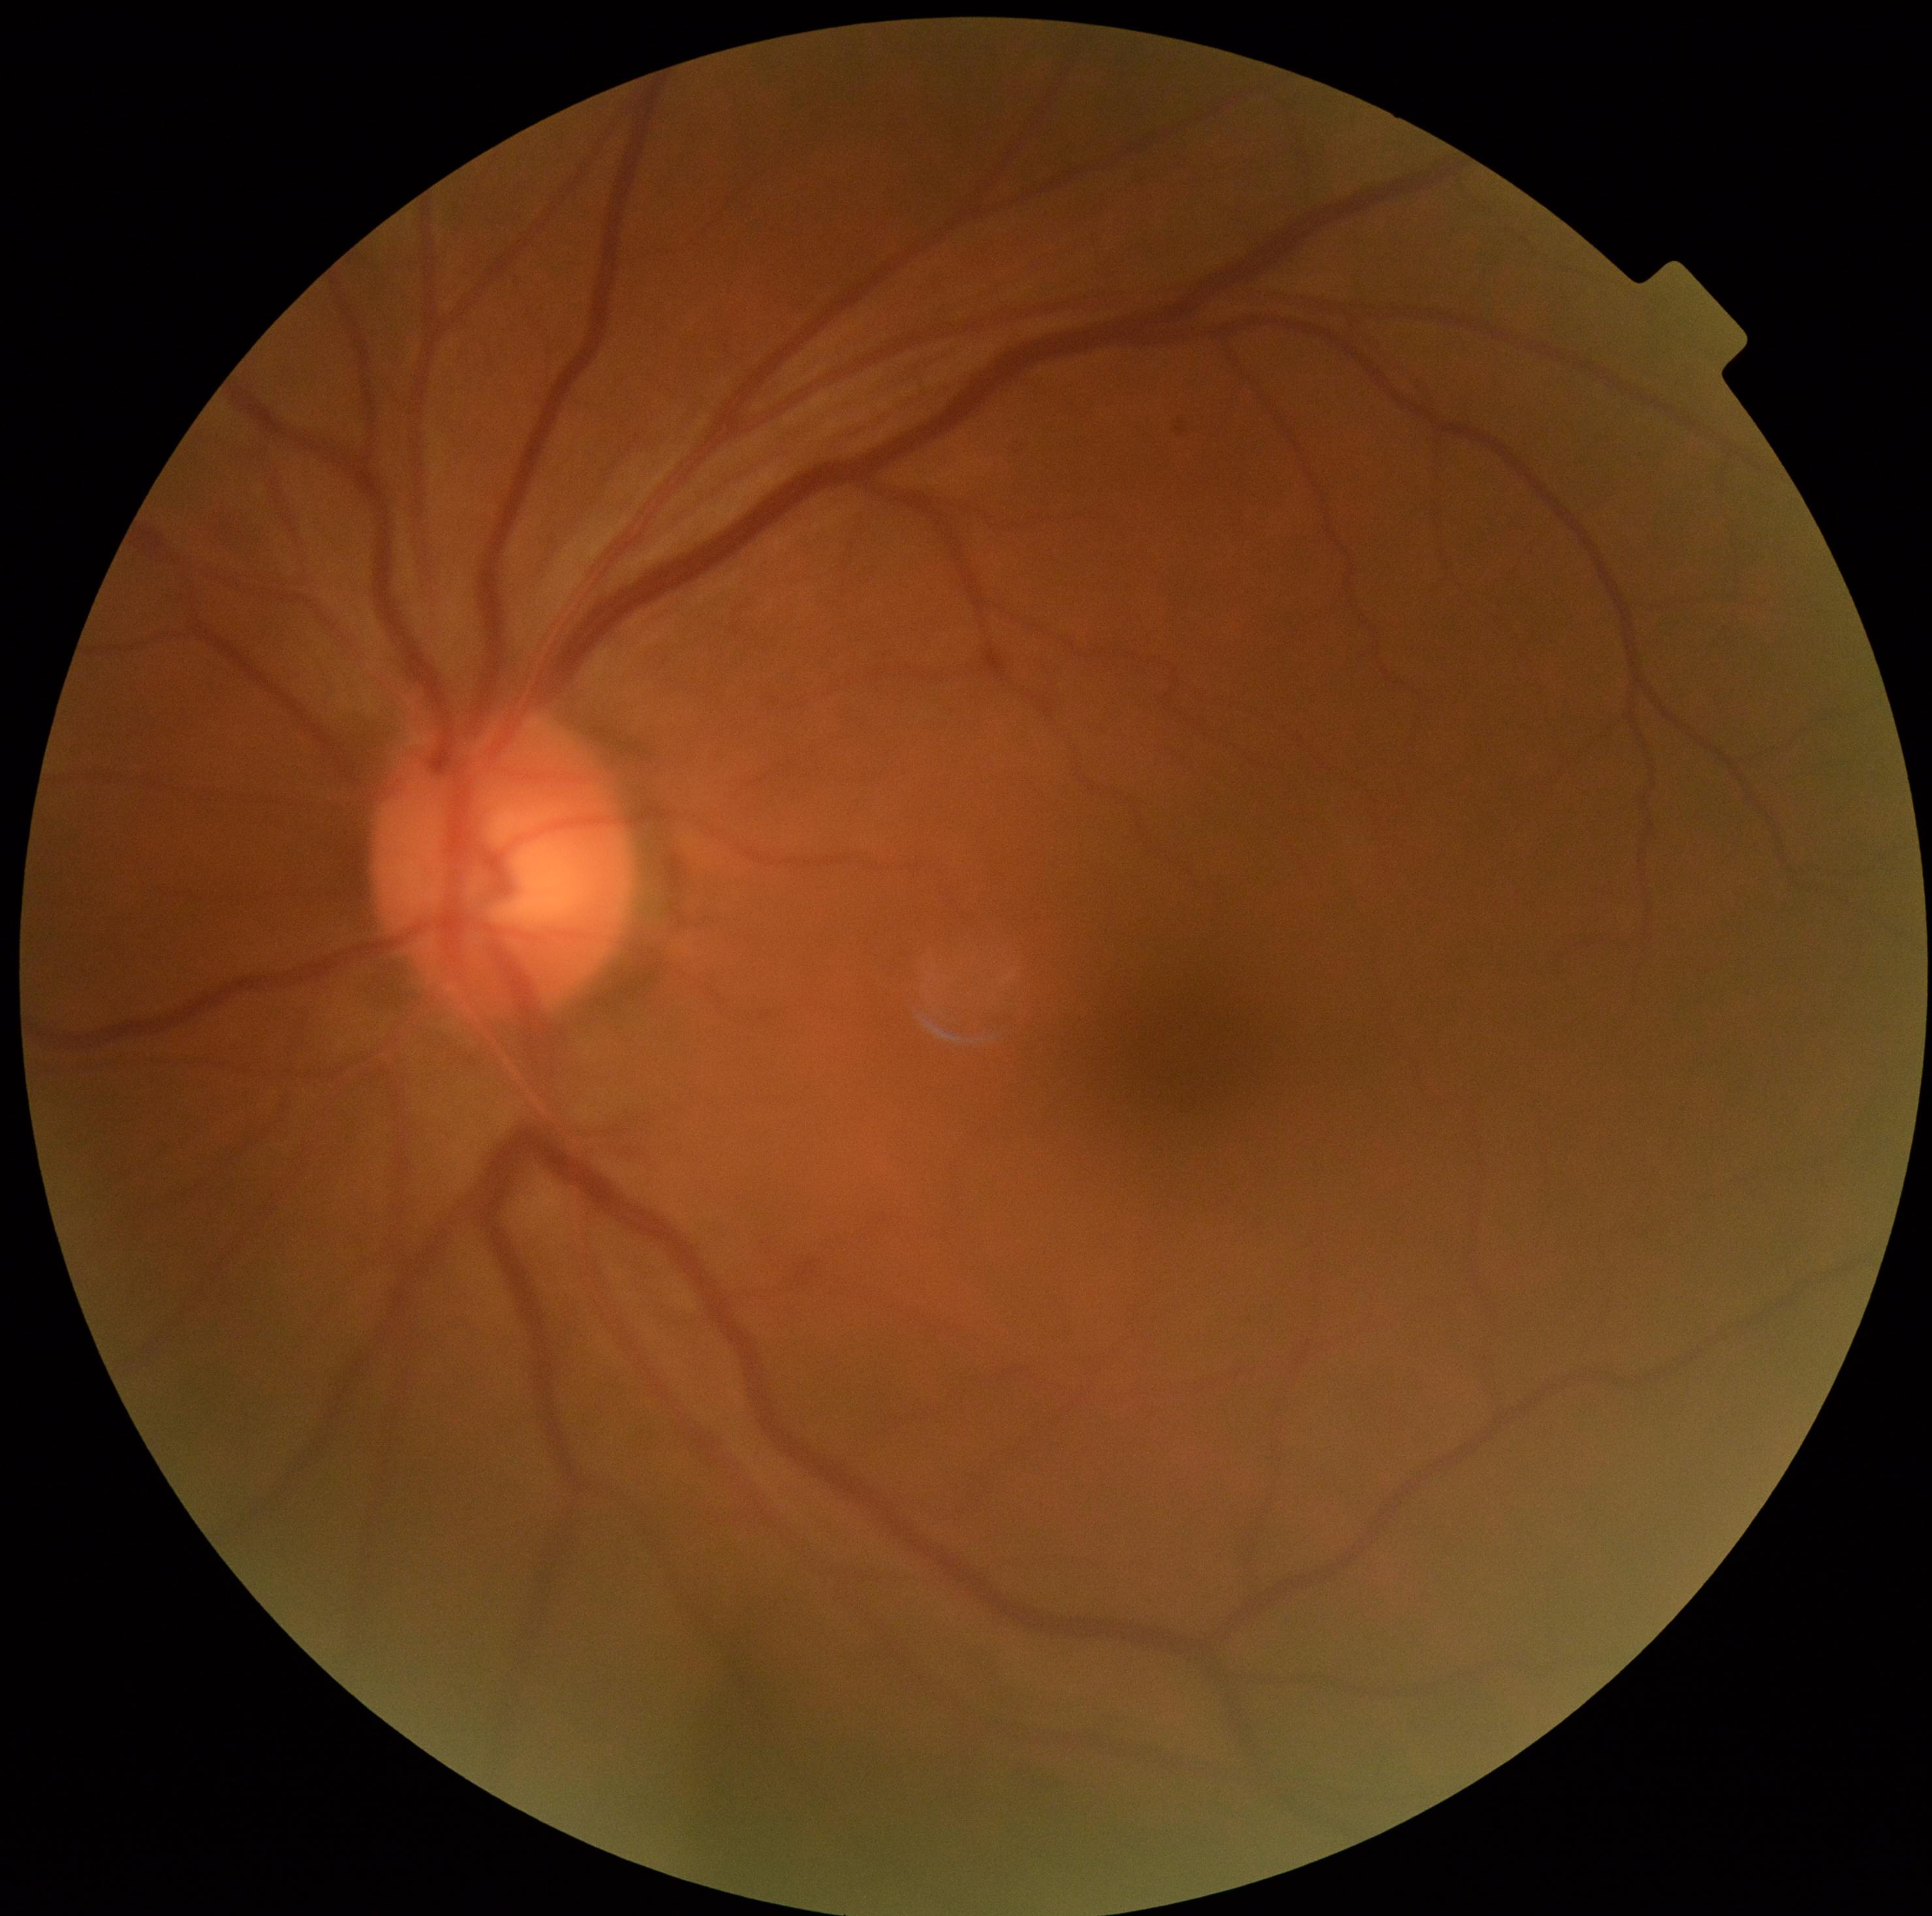 Retinopathy: grade 0 — no visible signs of diabetic retinopathy.